2212 by 1659 pixels · color fundus photograph: 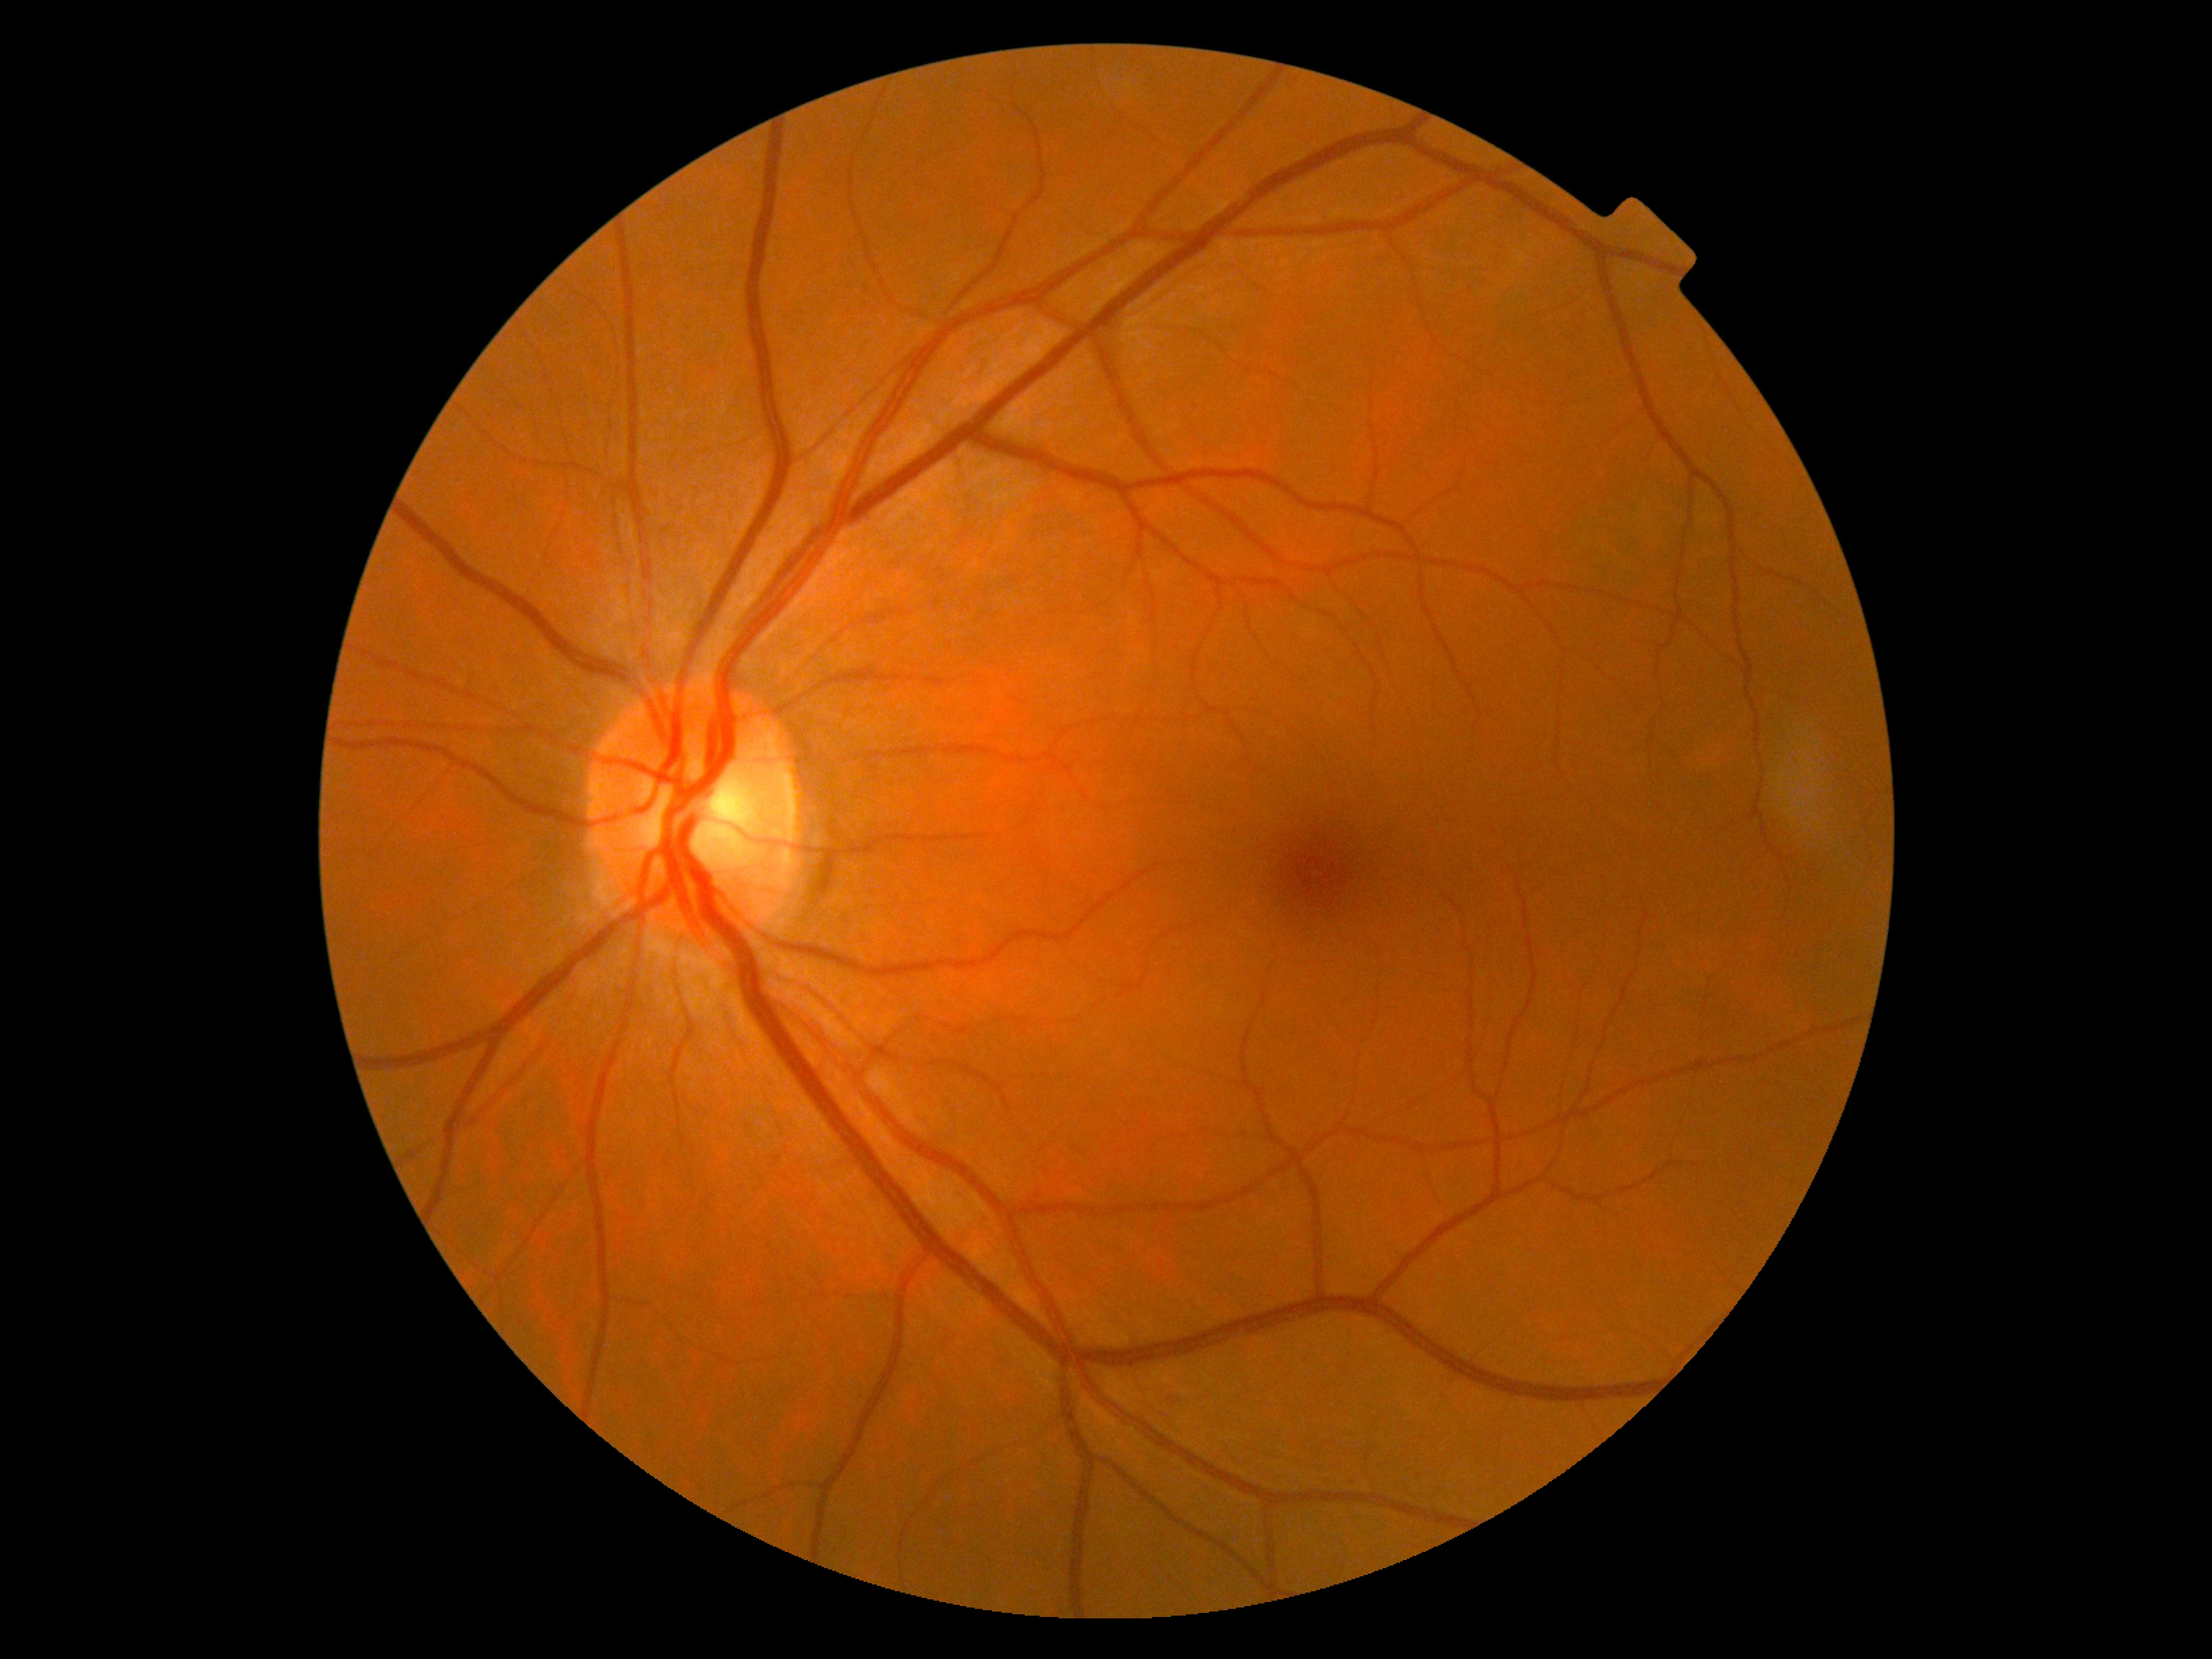
DR stage: grade 0 (no apparent retinopathy).